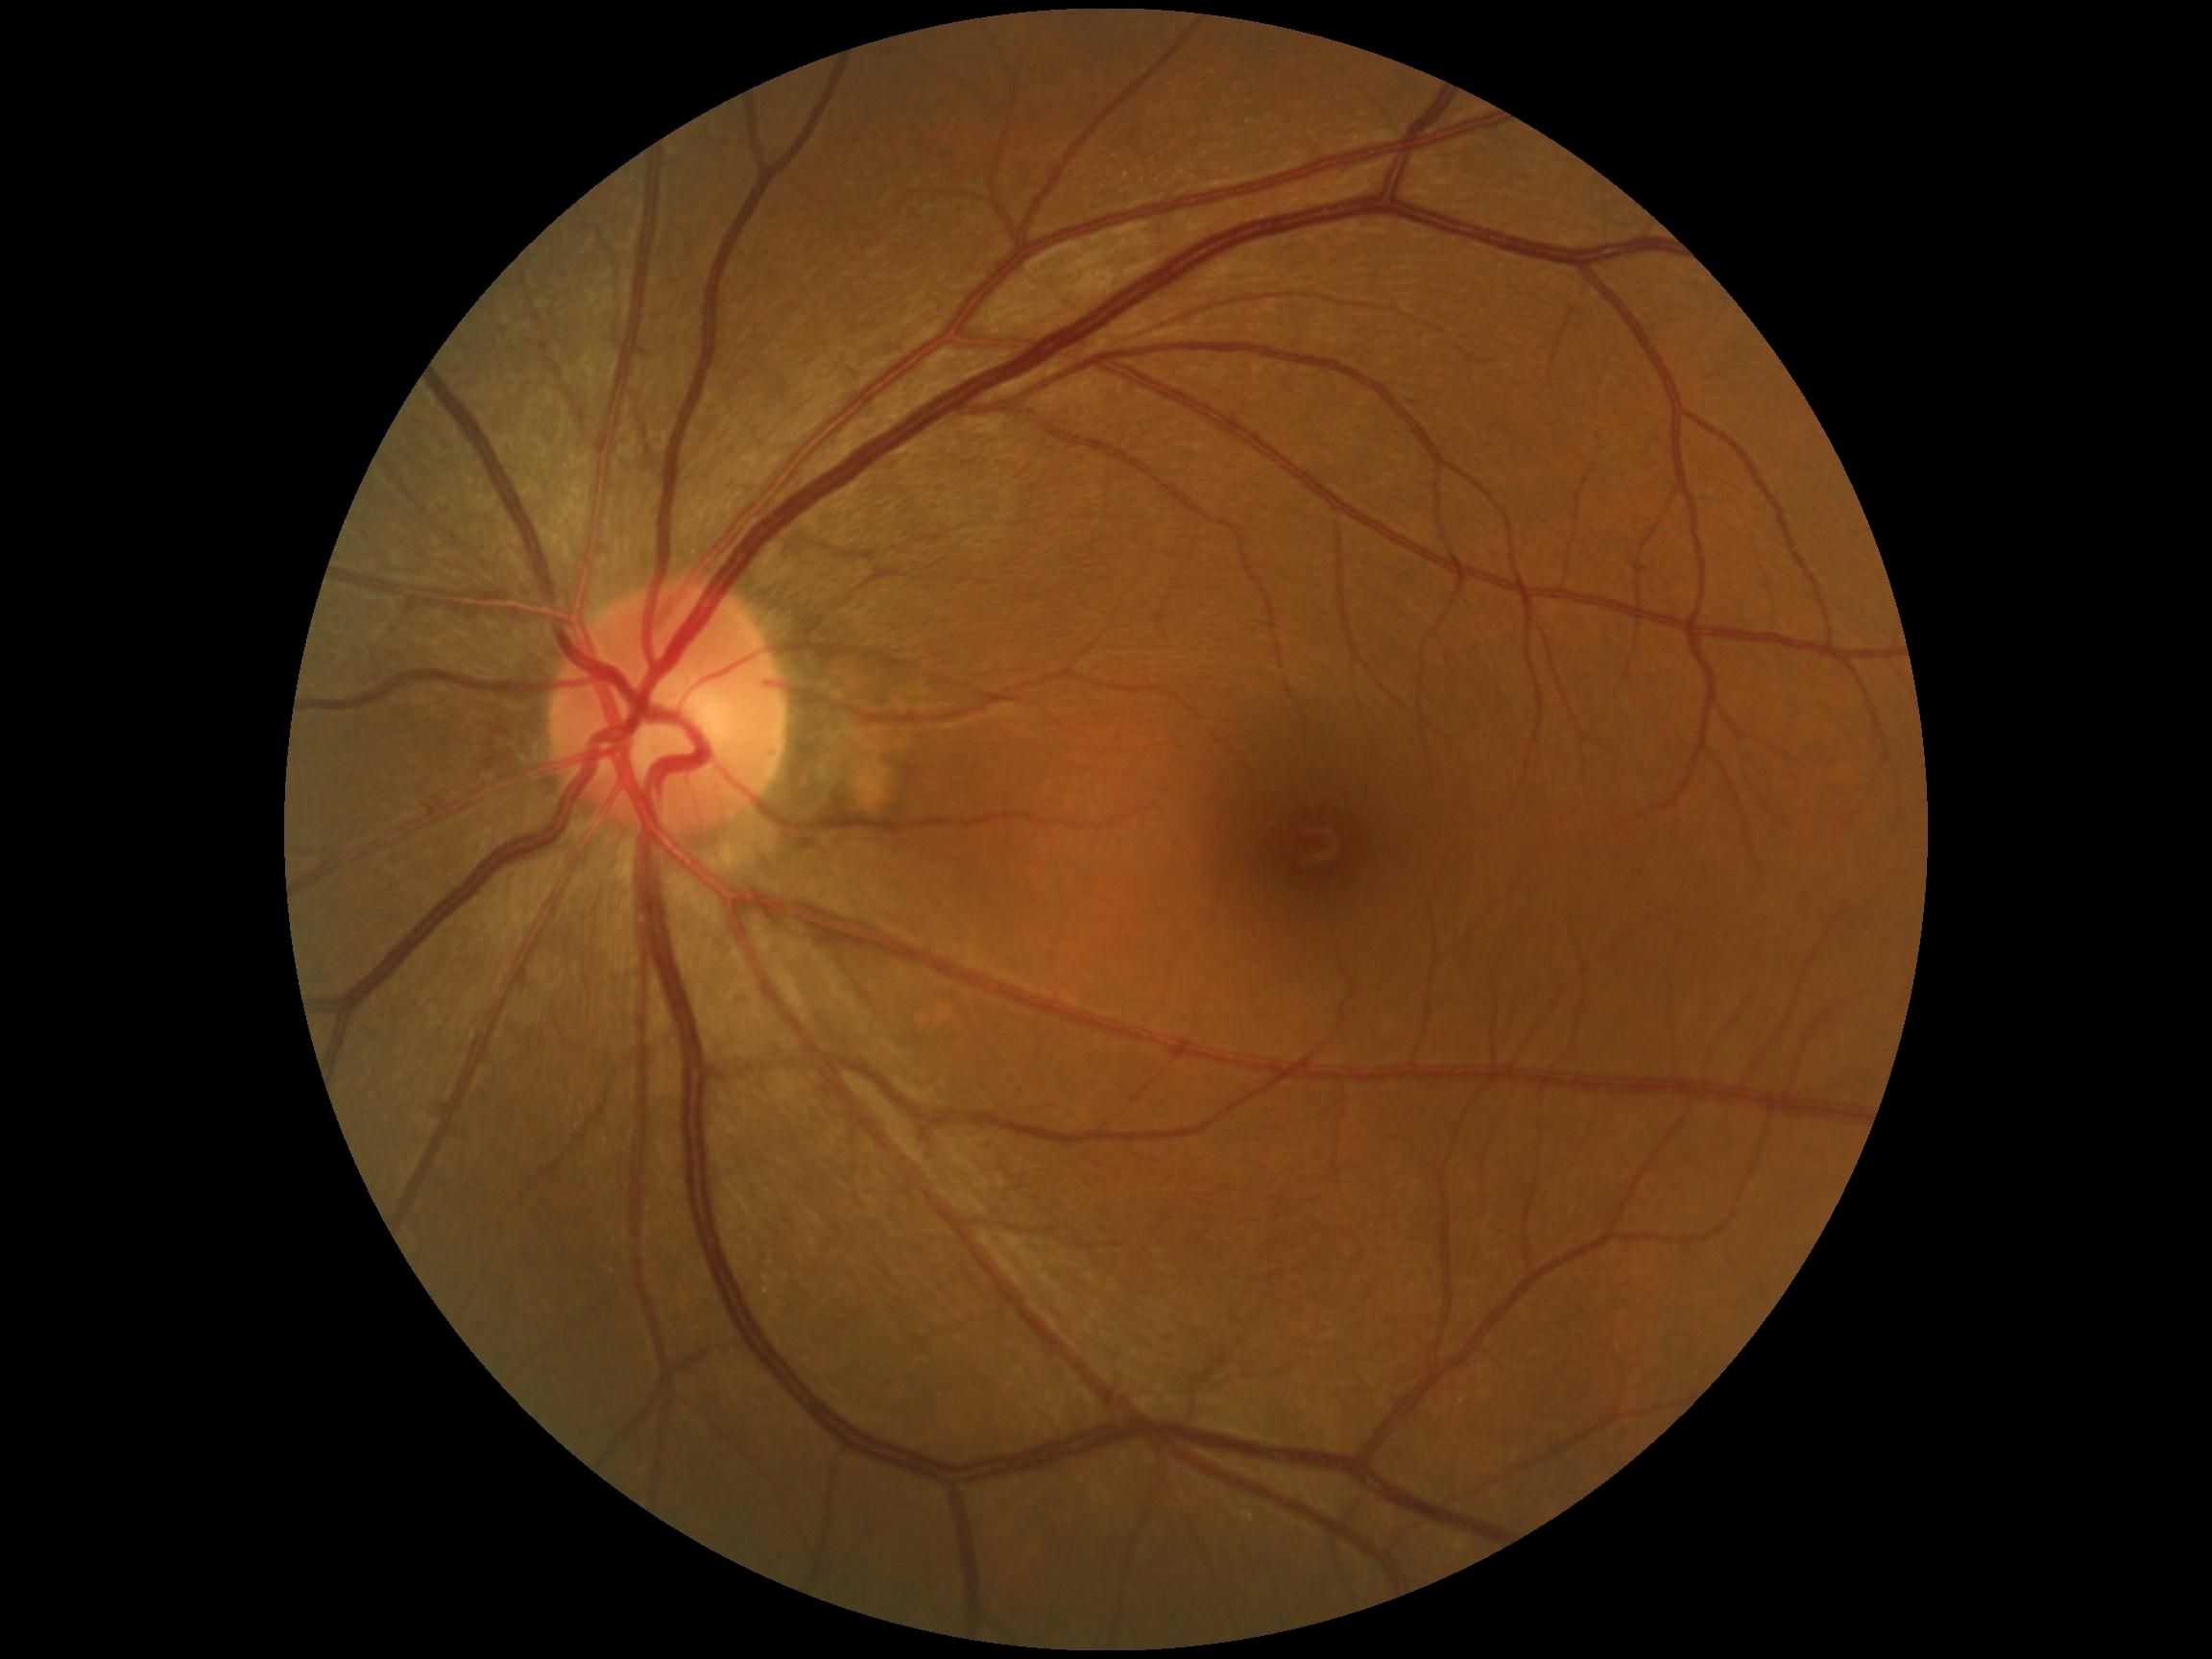
DR grade: no apparent retinopathy (0) — no visible signs of diabetic retinopathy.